Phoenix ICON wide-field infant fundus image.
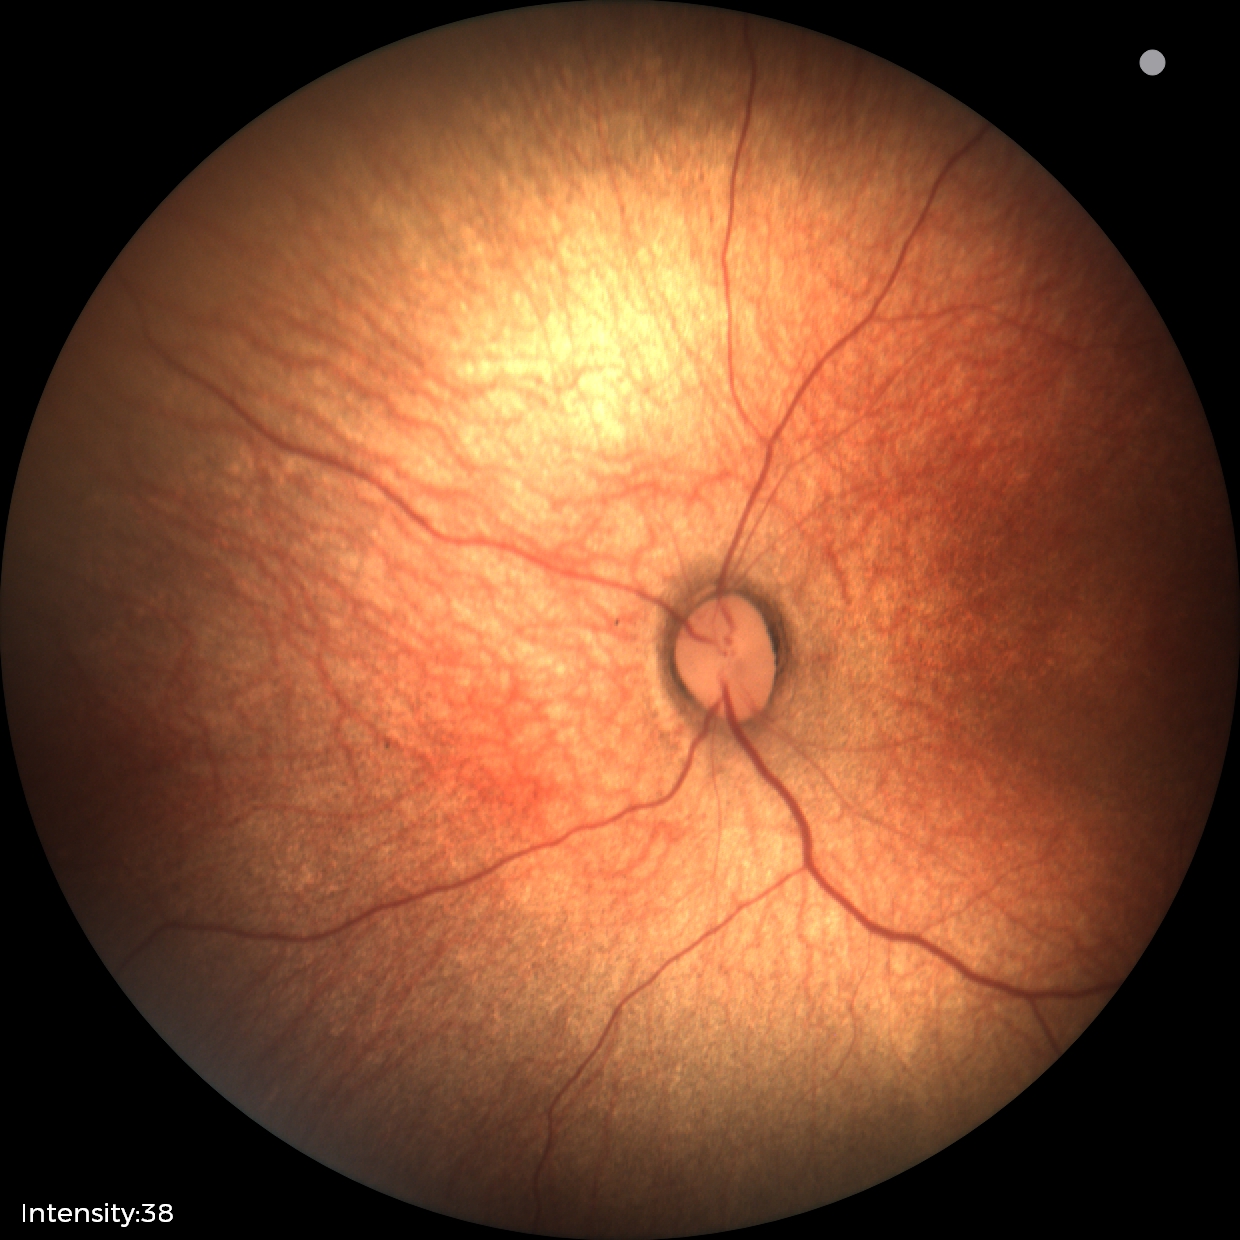

Examination with physiological retinal findings.